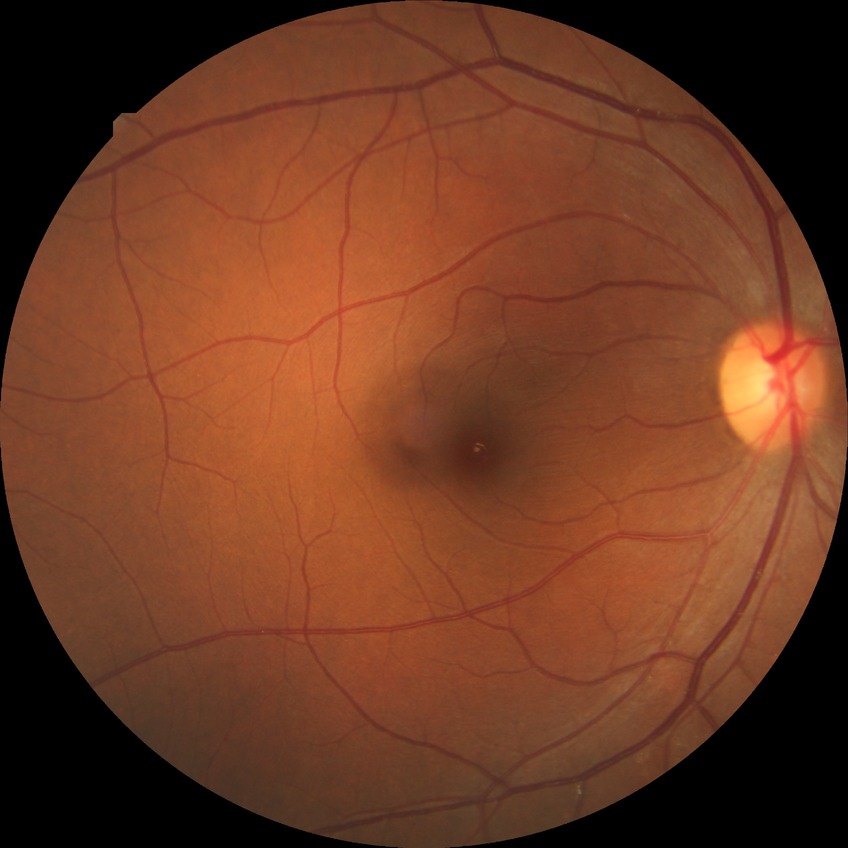
{
  "davis_grade": "no diabetic retinopathy"
}